Modified Davis classification.
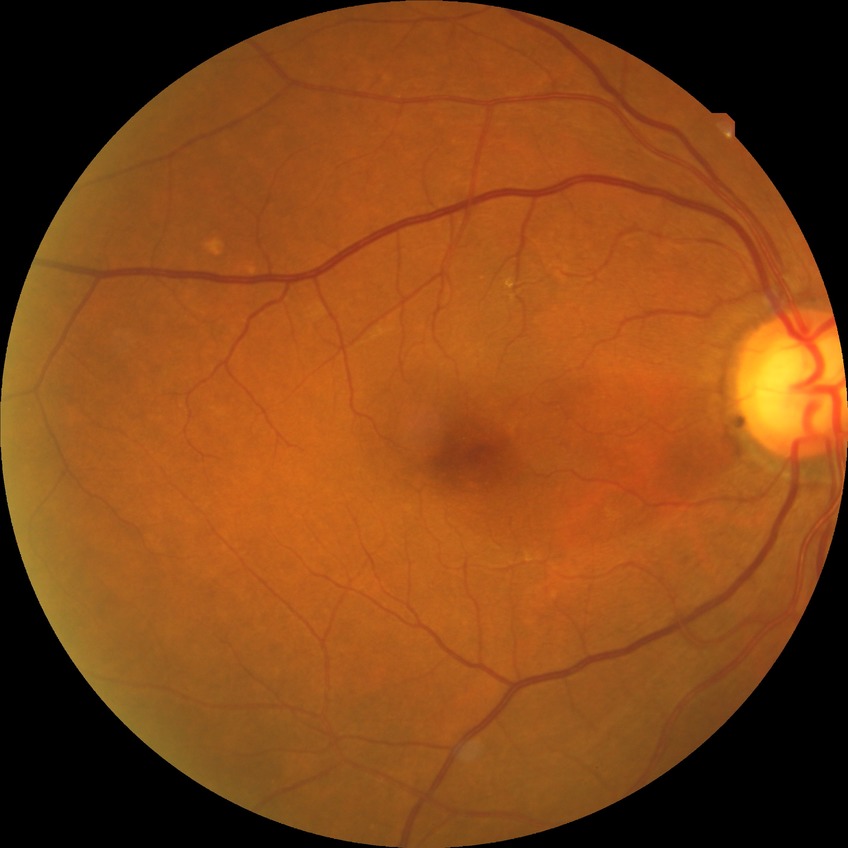 diabetic retinopathy (DR) = no diabetic retinopathy (NDR).